2352 x 1568 pixels
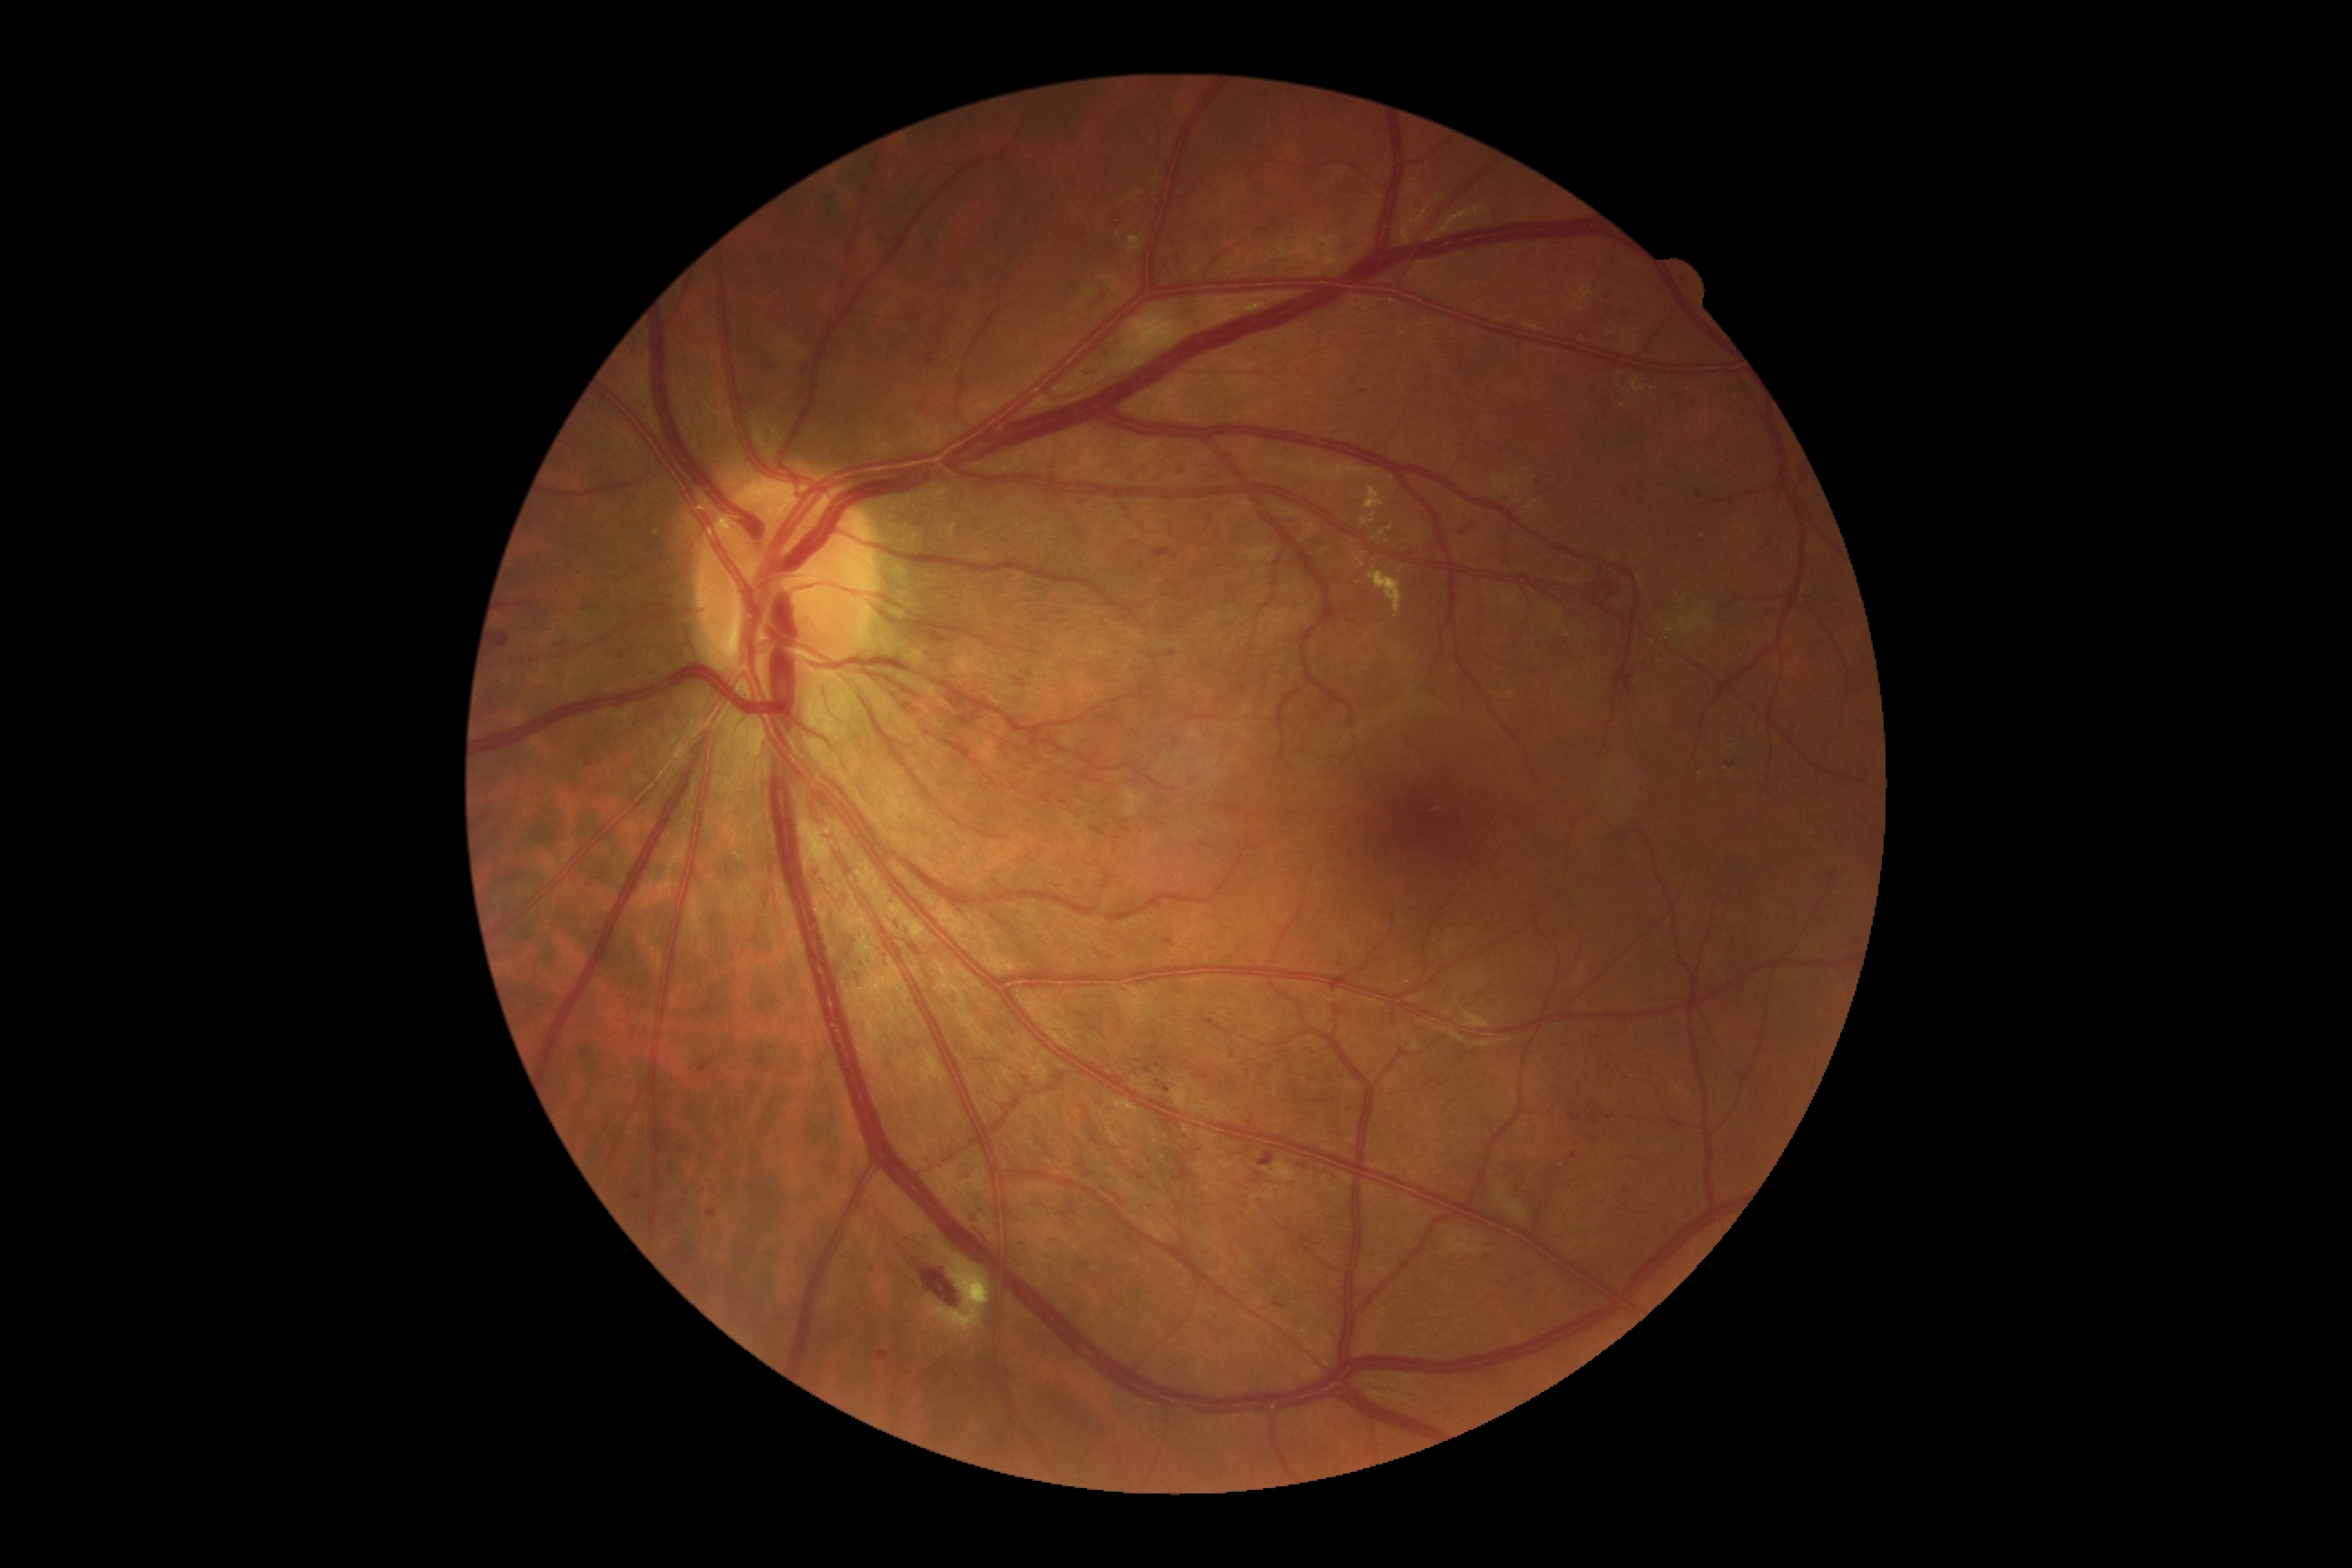

Retinopathy grade: 2 — more than just microaneurysms but less than severe NPDR
Lesions identified (partial list):
hemorrhages (partial): bbox=[903, 1233, 914, 1244] | bbox=[516, 602, 536, 607] | bbox=[1068, 284, 1077, 291] | bbox=[576, 569, 582, 578] | bbox=[1636, 916, 1649, 923] | bbox=[761, 426, 776, 447] | bbox=[1620, 375, 1629, 384] | bbox=[1602, 1115, 1612, 1121] | bbox=[1257, 1153, 1275, 1168] | bbox=[1676, 275, 1687, 286] | bbox=[1464, 514, 1469, 522] | bbox=[936, 1144, 952, 1157] | bbox=[1482, 1240, 1493, 1250] | bbox=[1587, 574, 1622, 600] | bbox=[1589, 1113, 1600, 1126] | bbox=[1014, 678, 1028, 689]
Small hemorrhages near 1539/484 | 872/1271 | 1480/996 | 1609/1068